Color fundus image · 2212x1659.
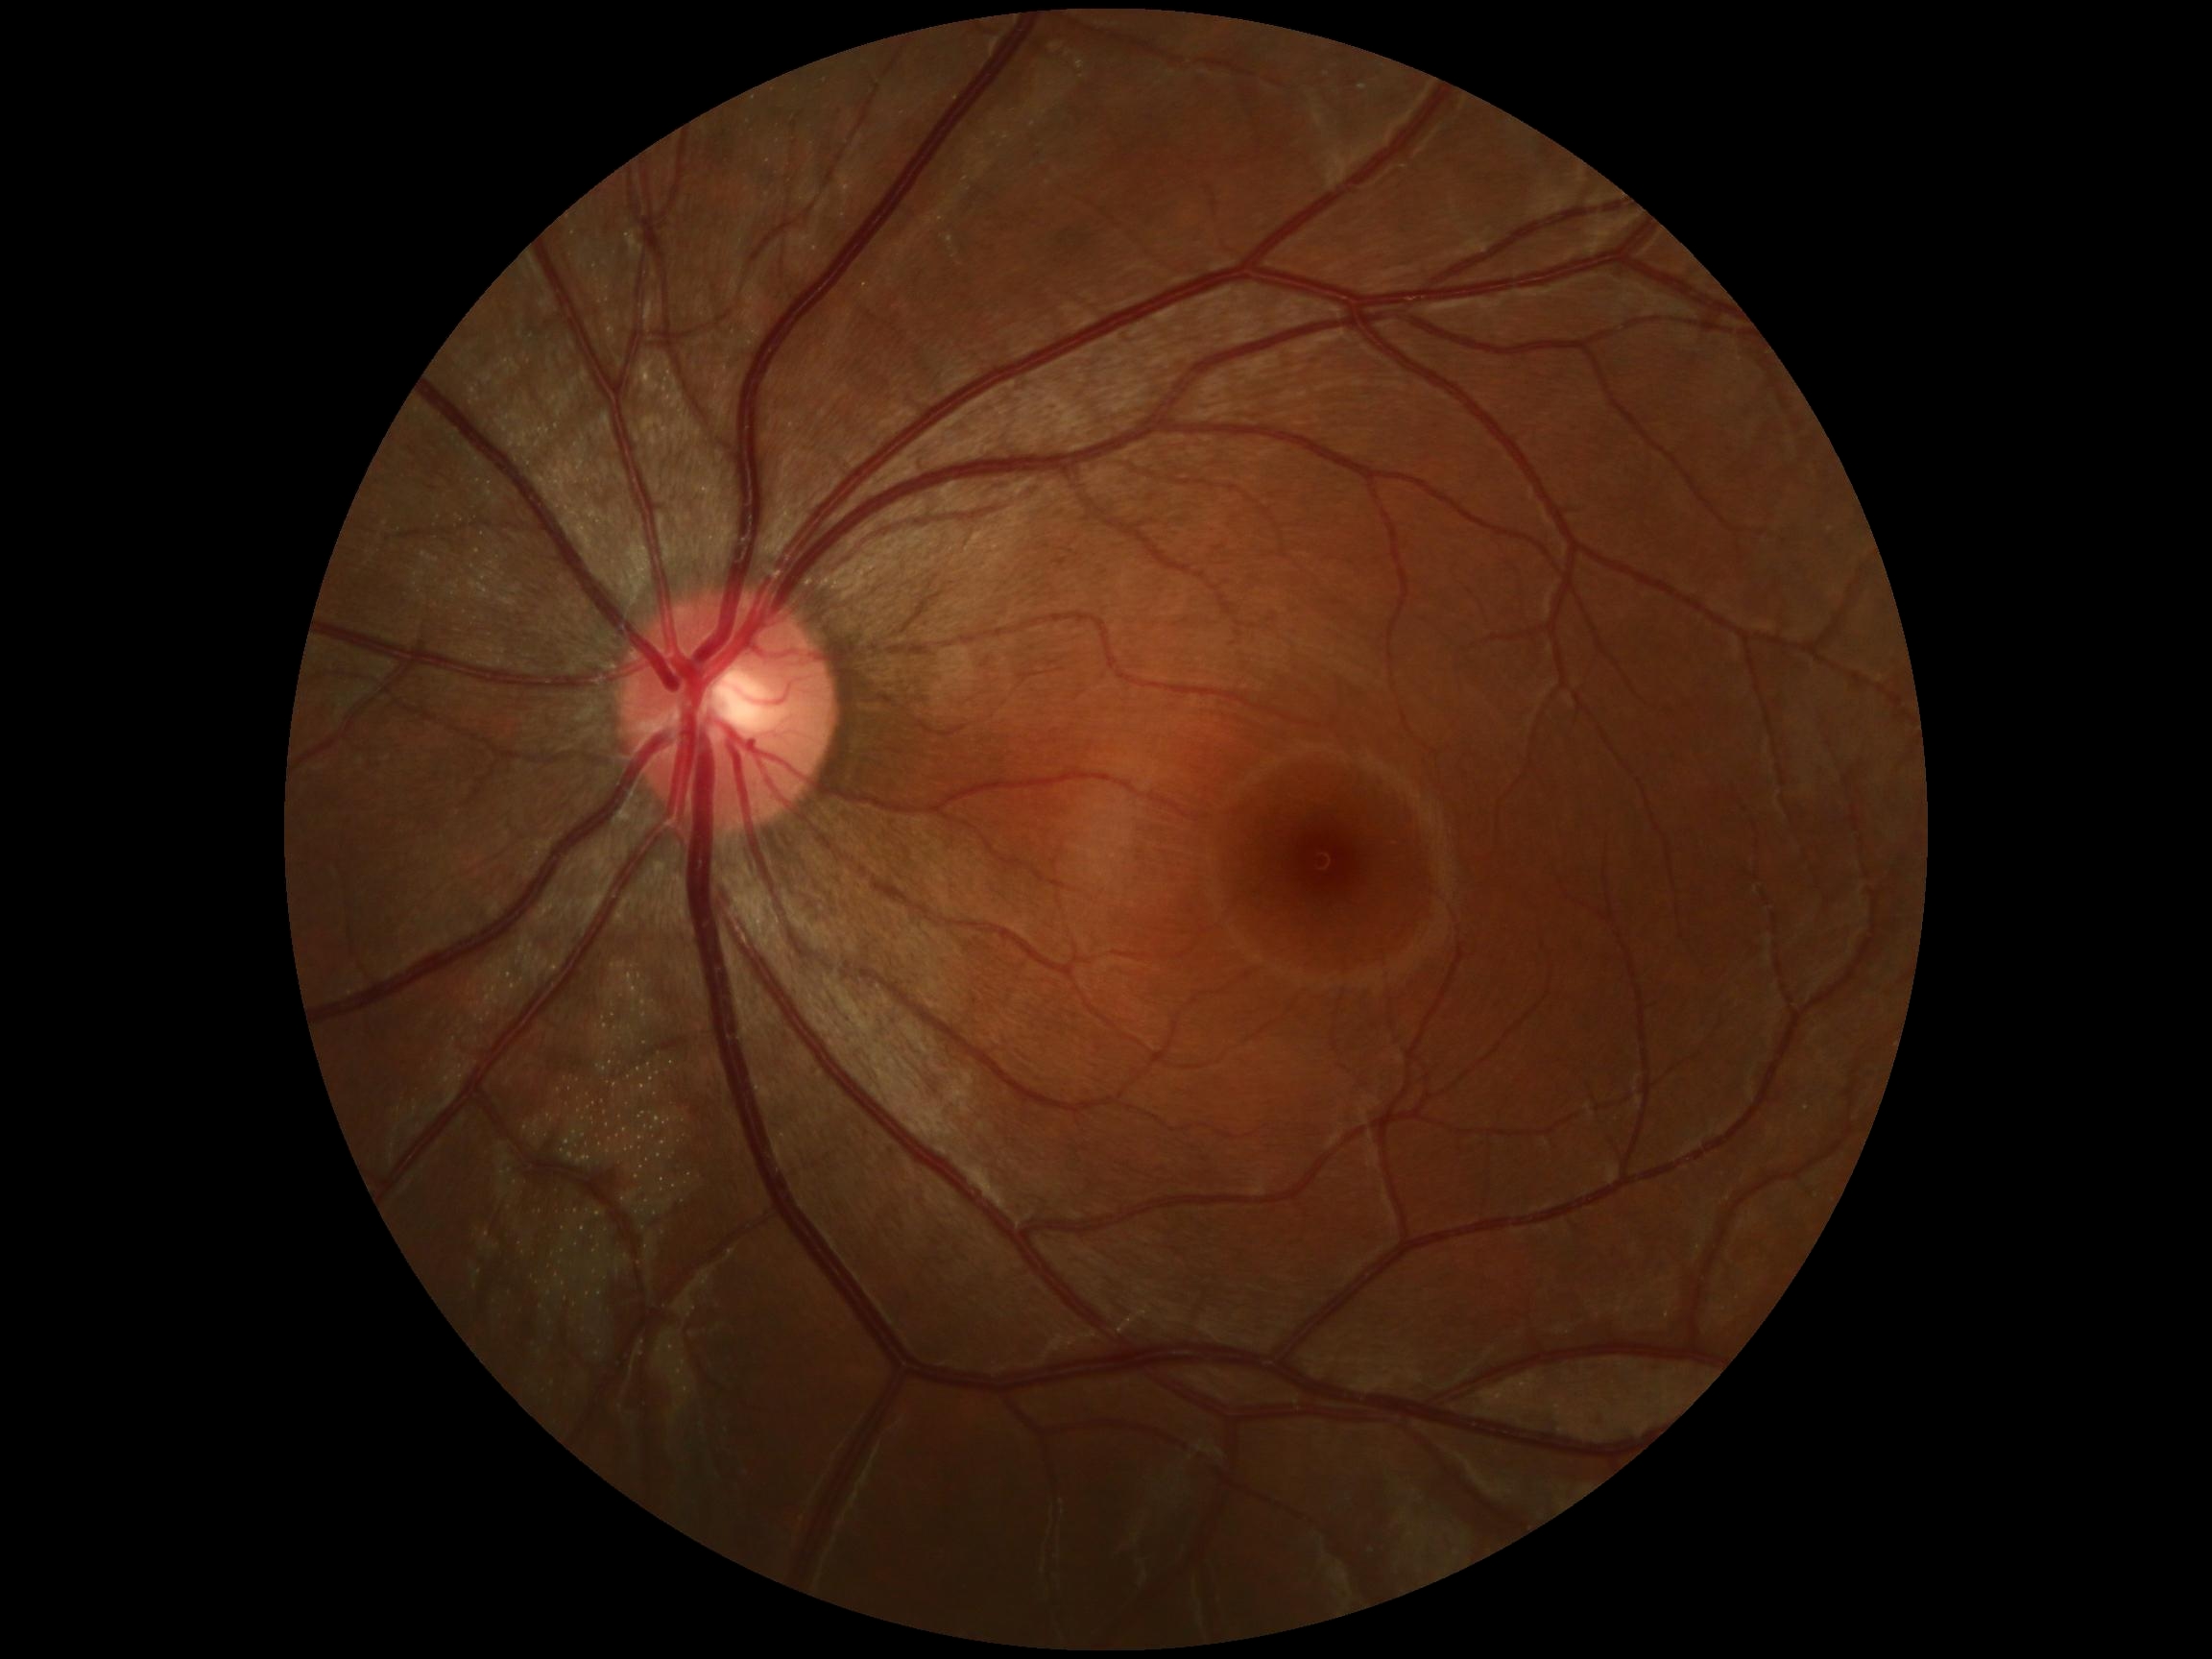
DR impression: no DR findings | DR severity: grade 0.